Modified Davis grading
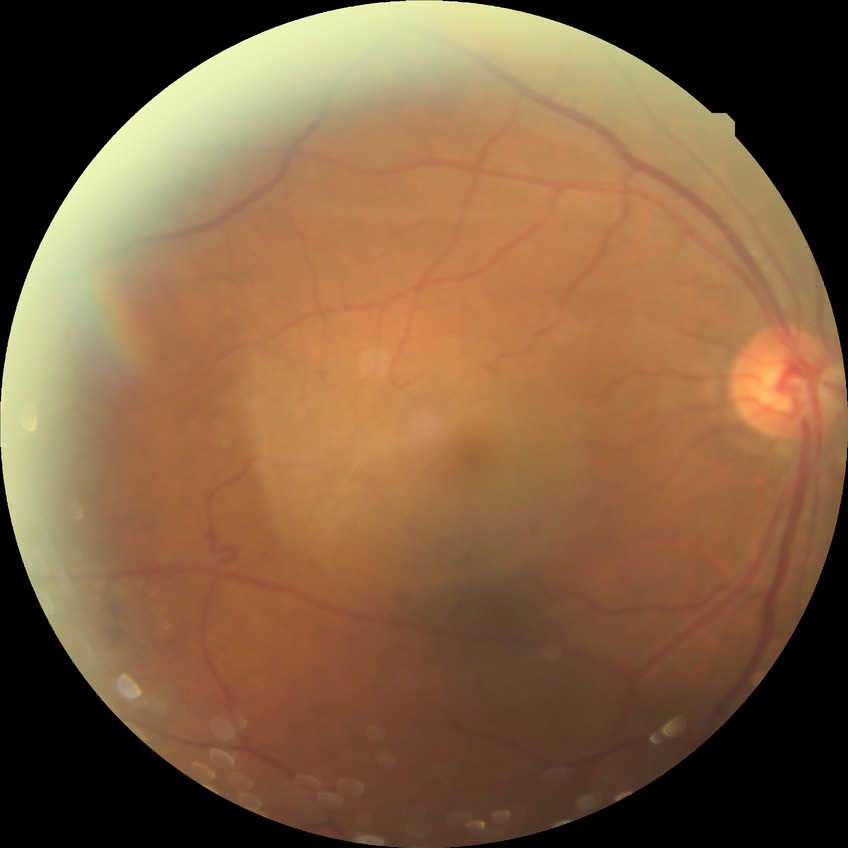
Diabetic retinopathy (DR) is SDR (simple diabetic retinopathy).